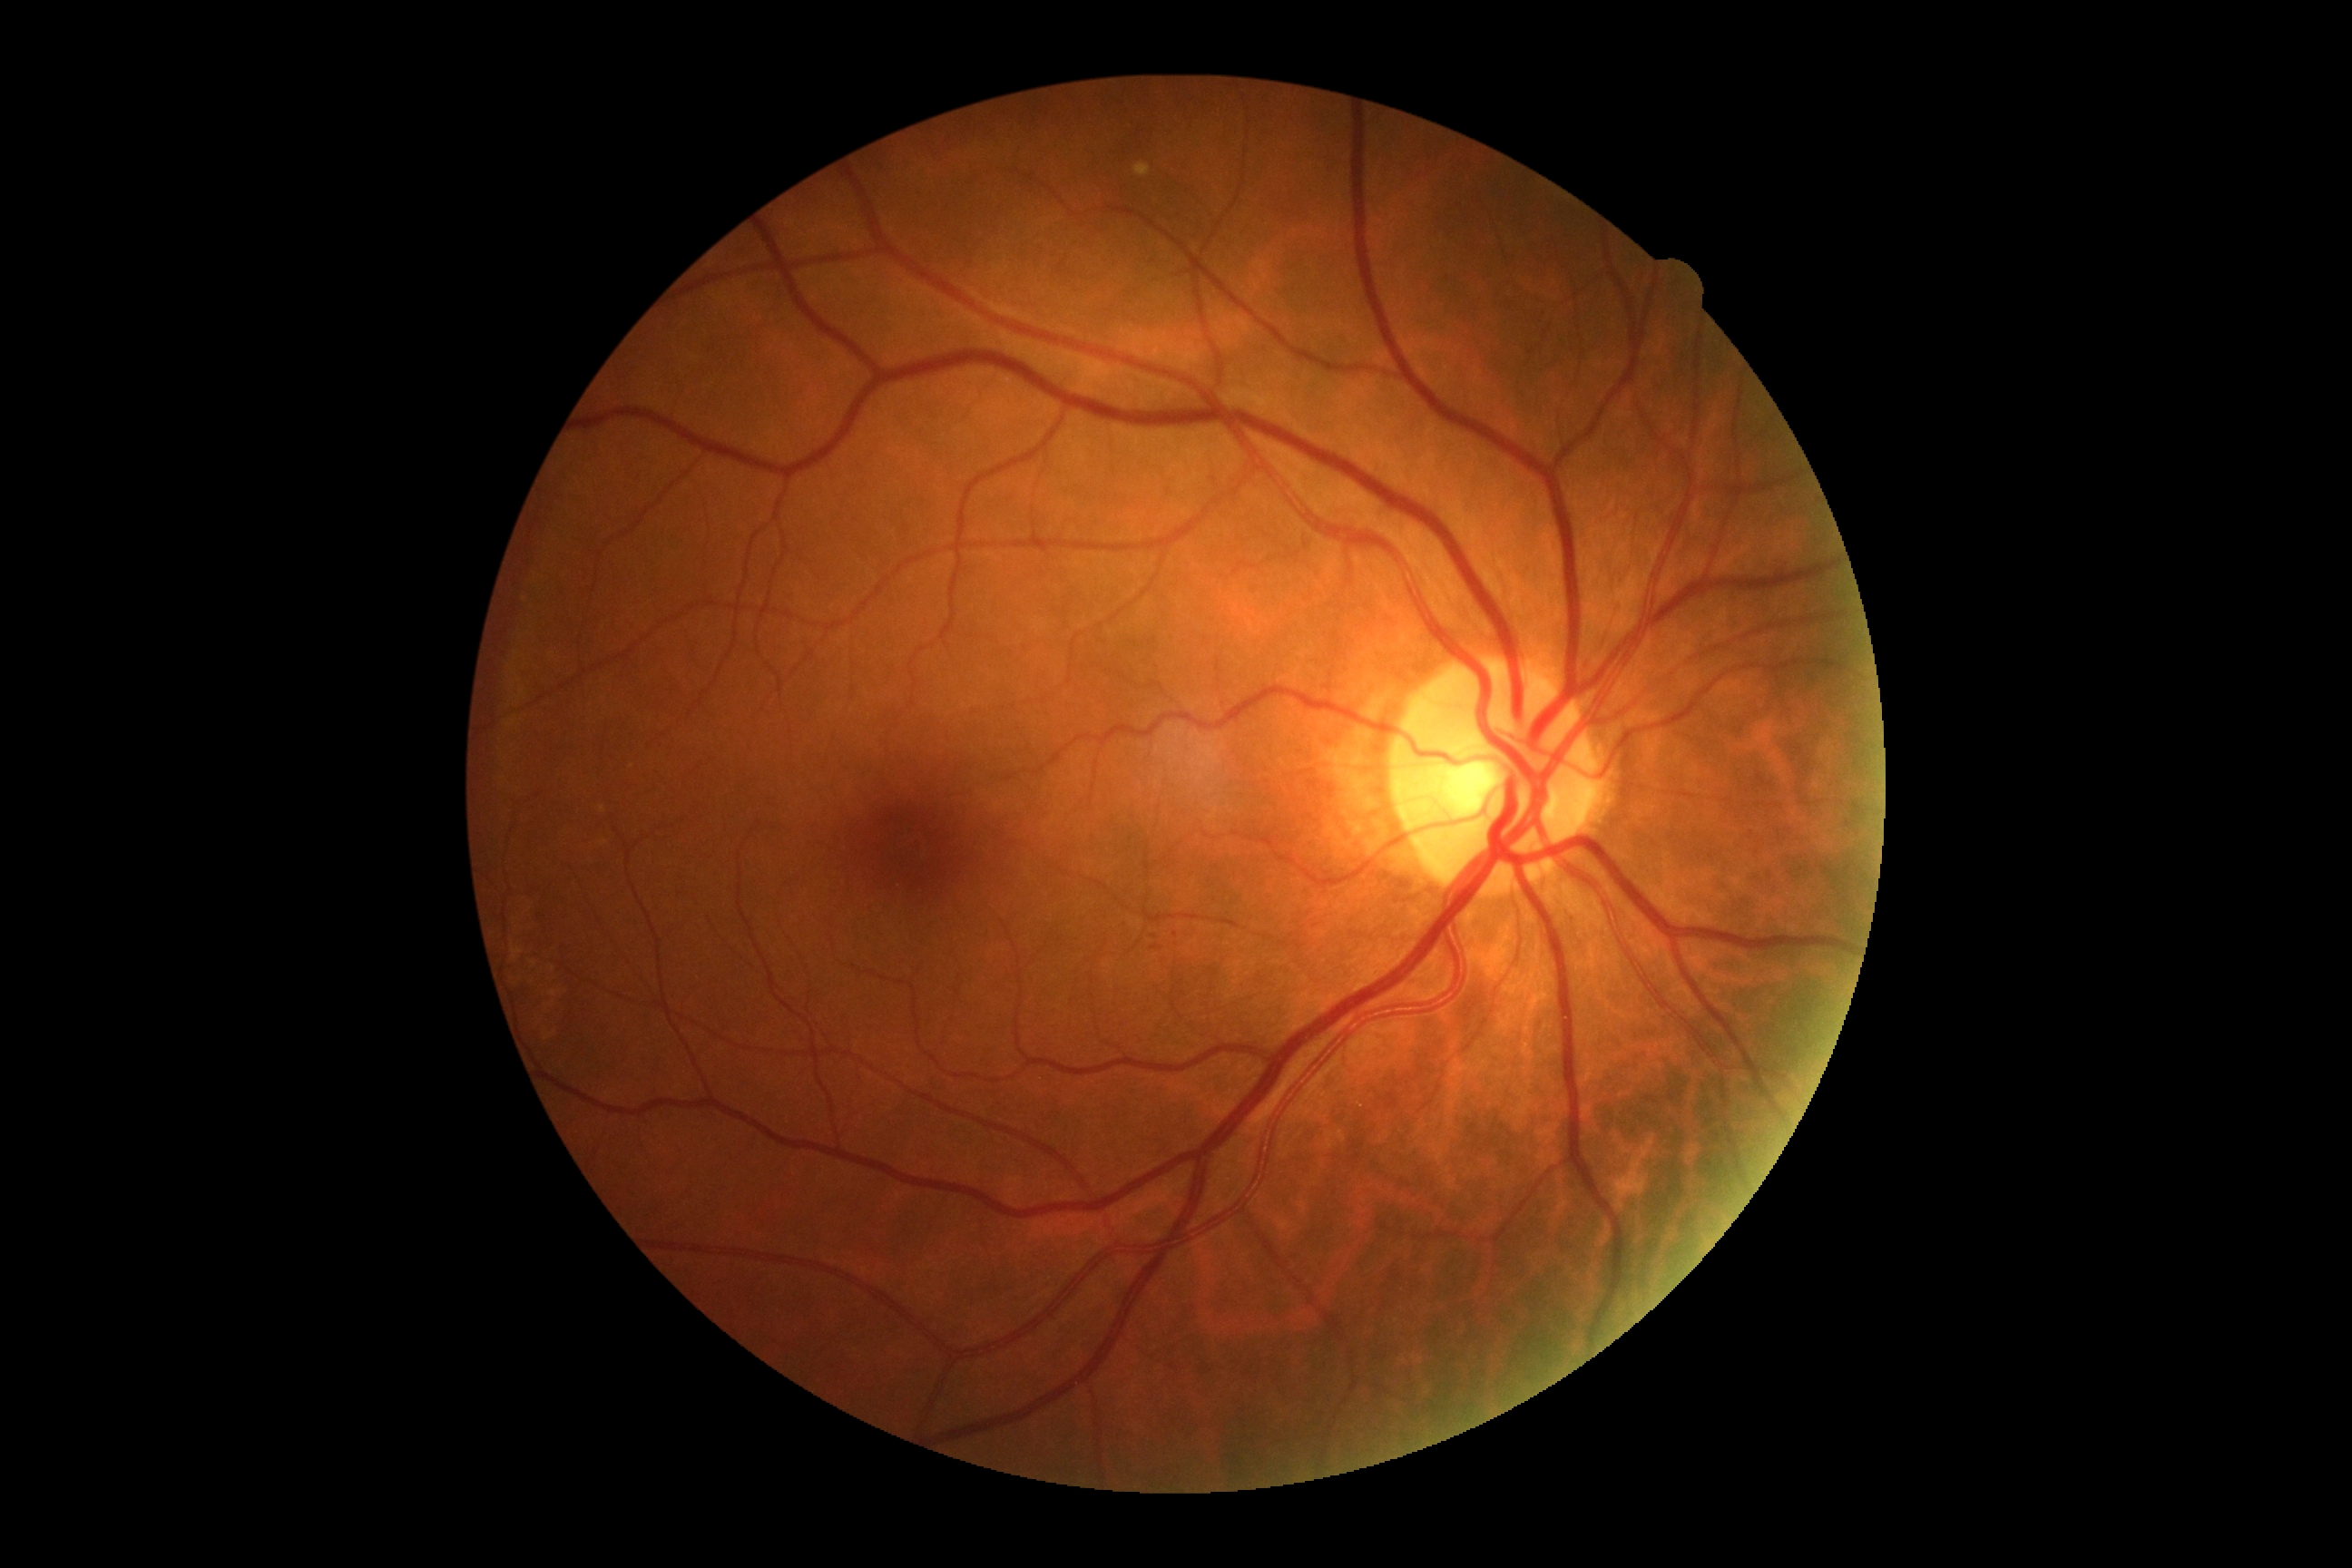

Diabetic retinopathy: 0/4 — no visible signs of diabetic retinopathy.